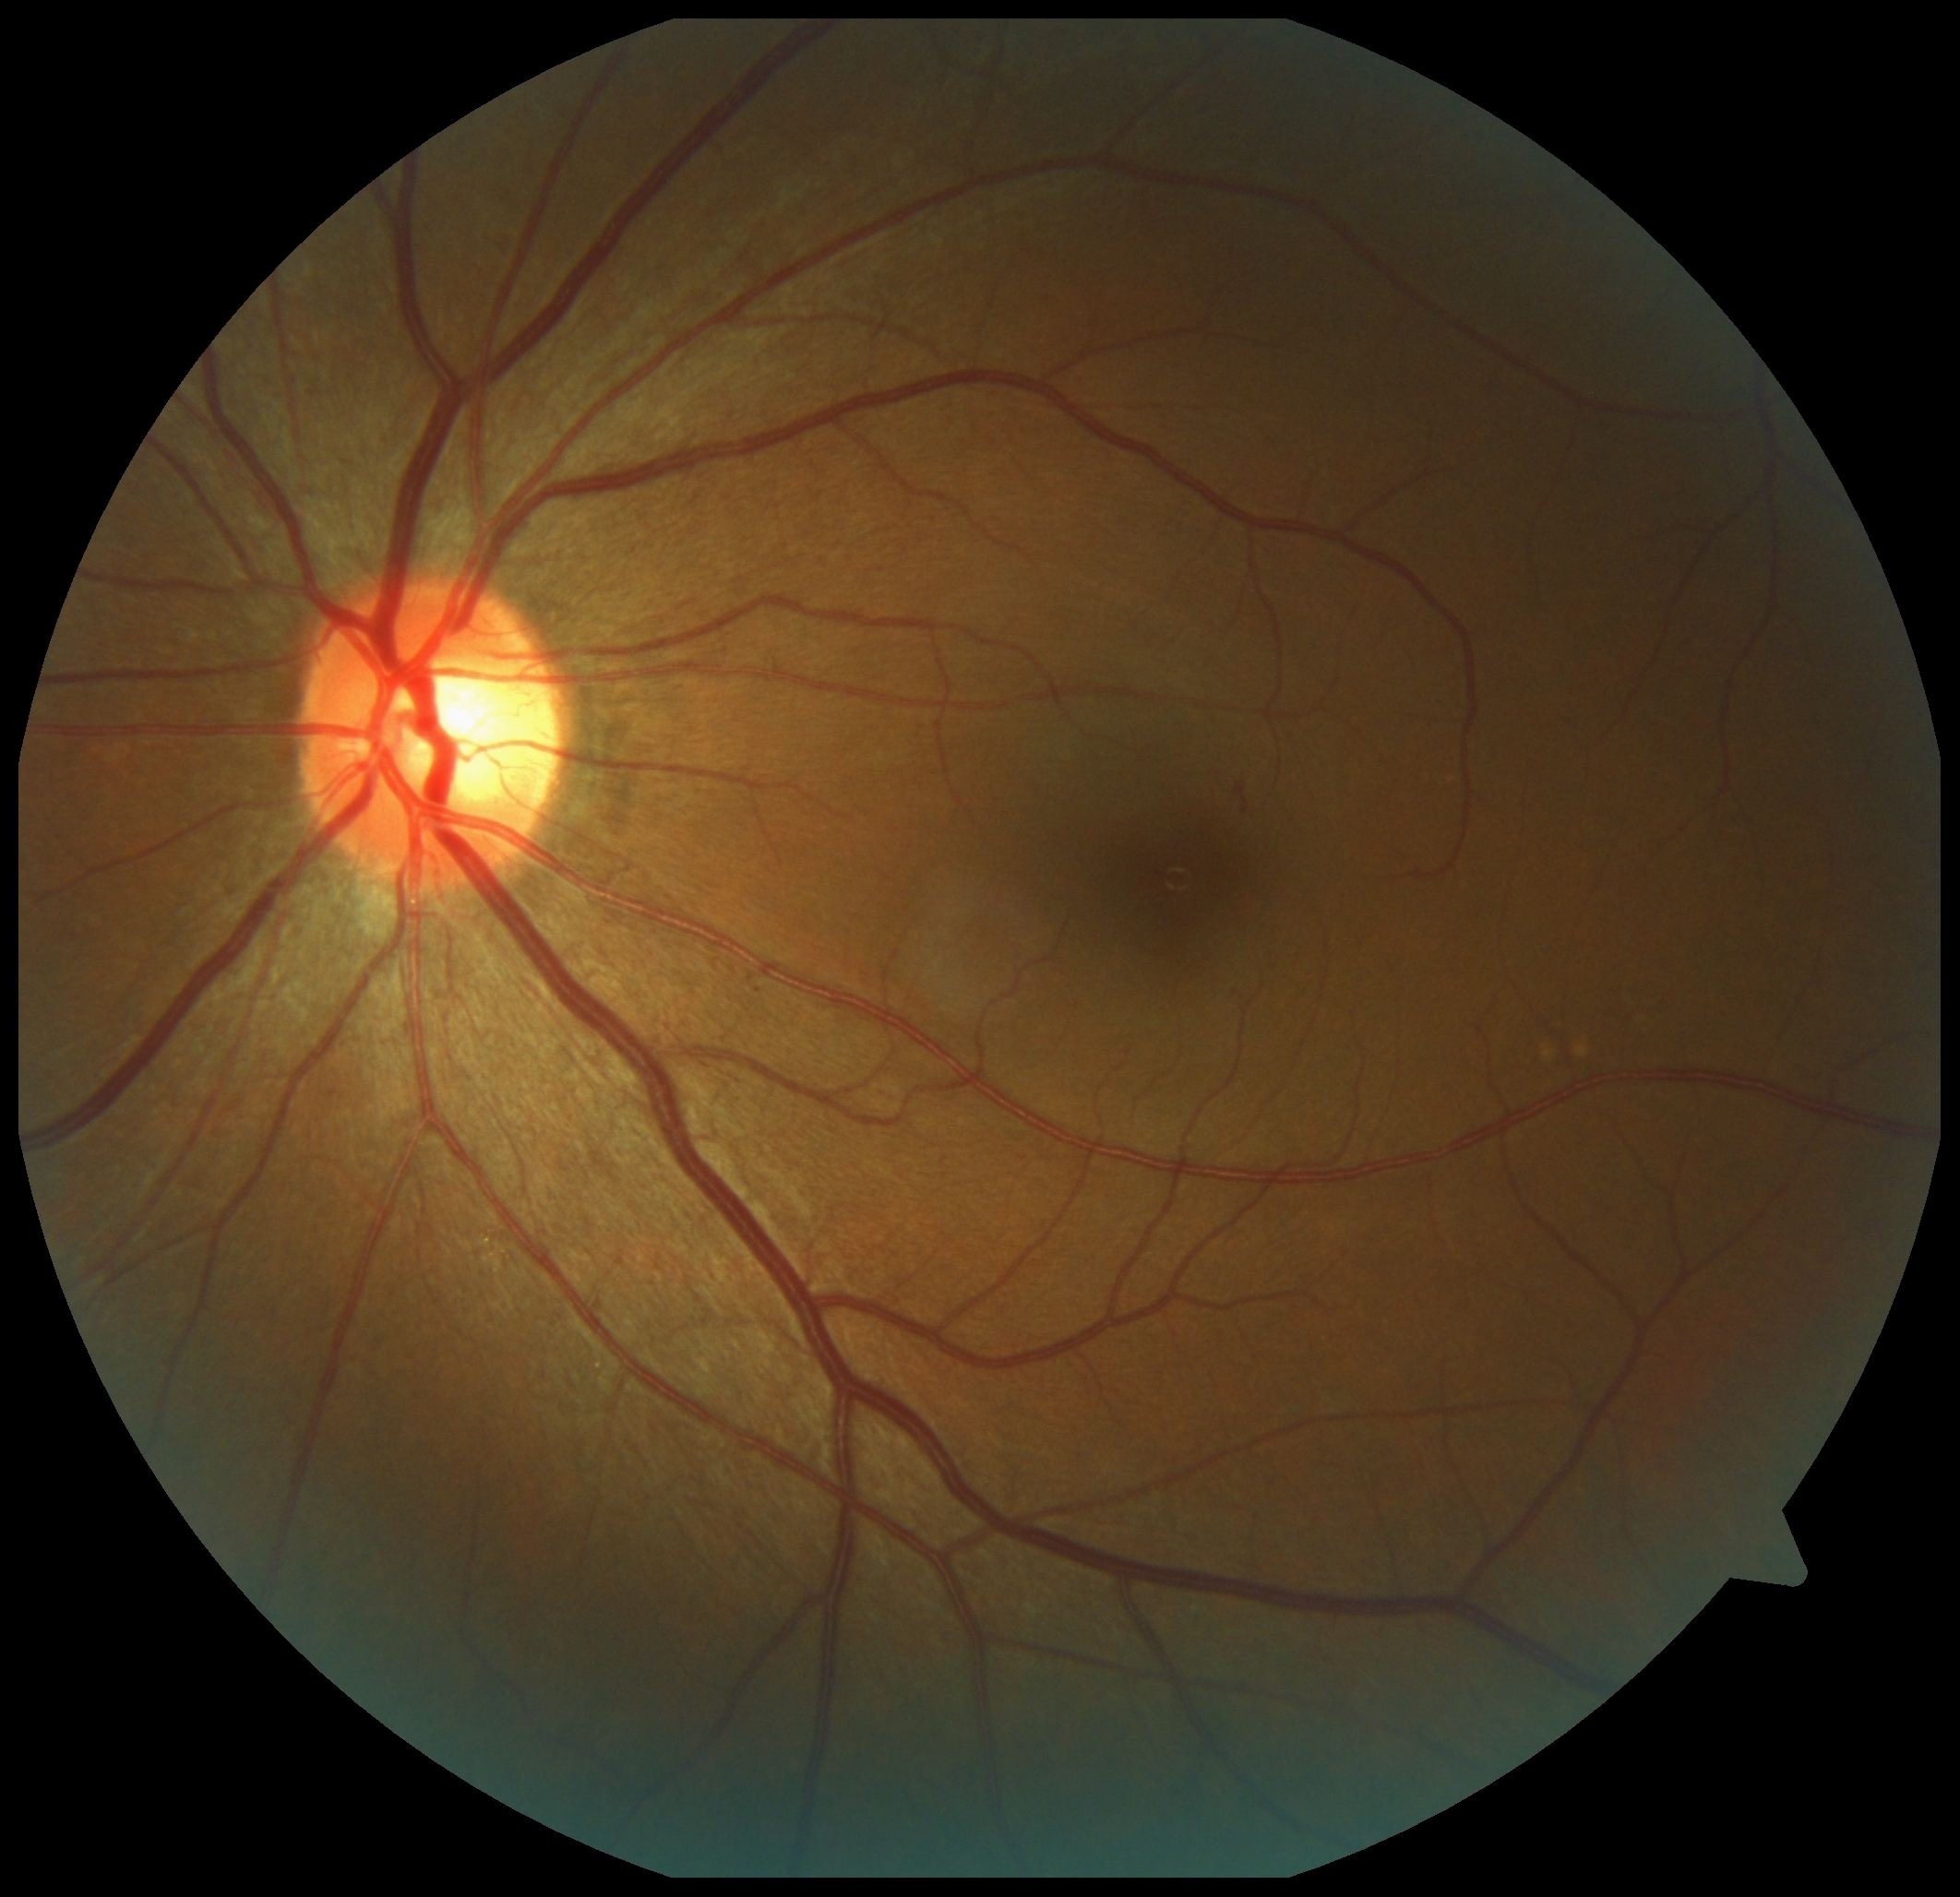 DR severity: 2/4 — more than just microaneurysms but less than severe NPDR.